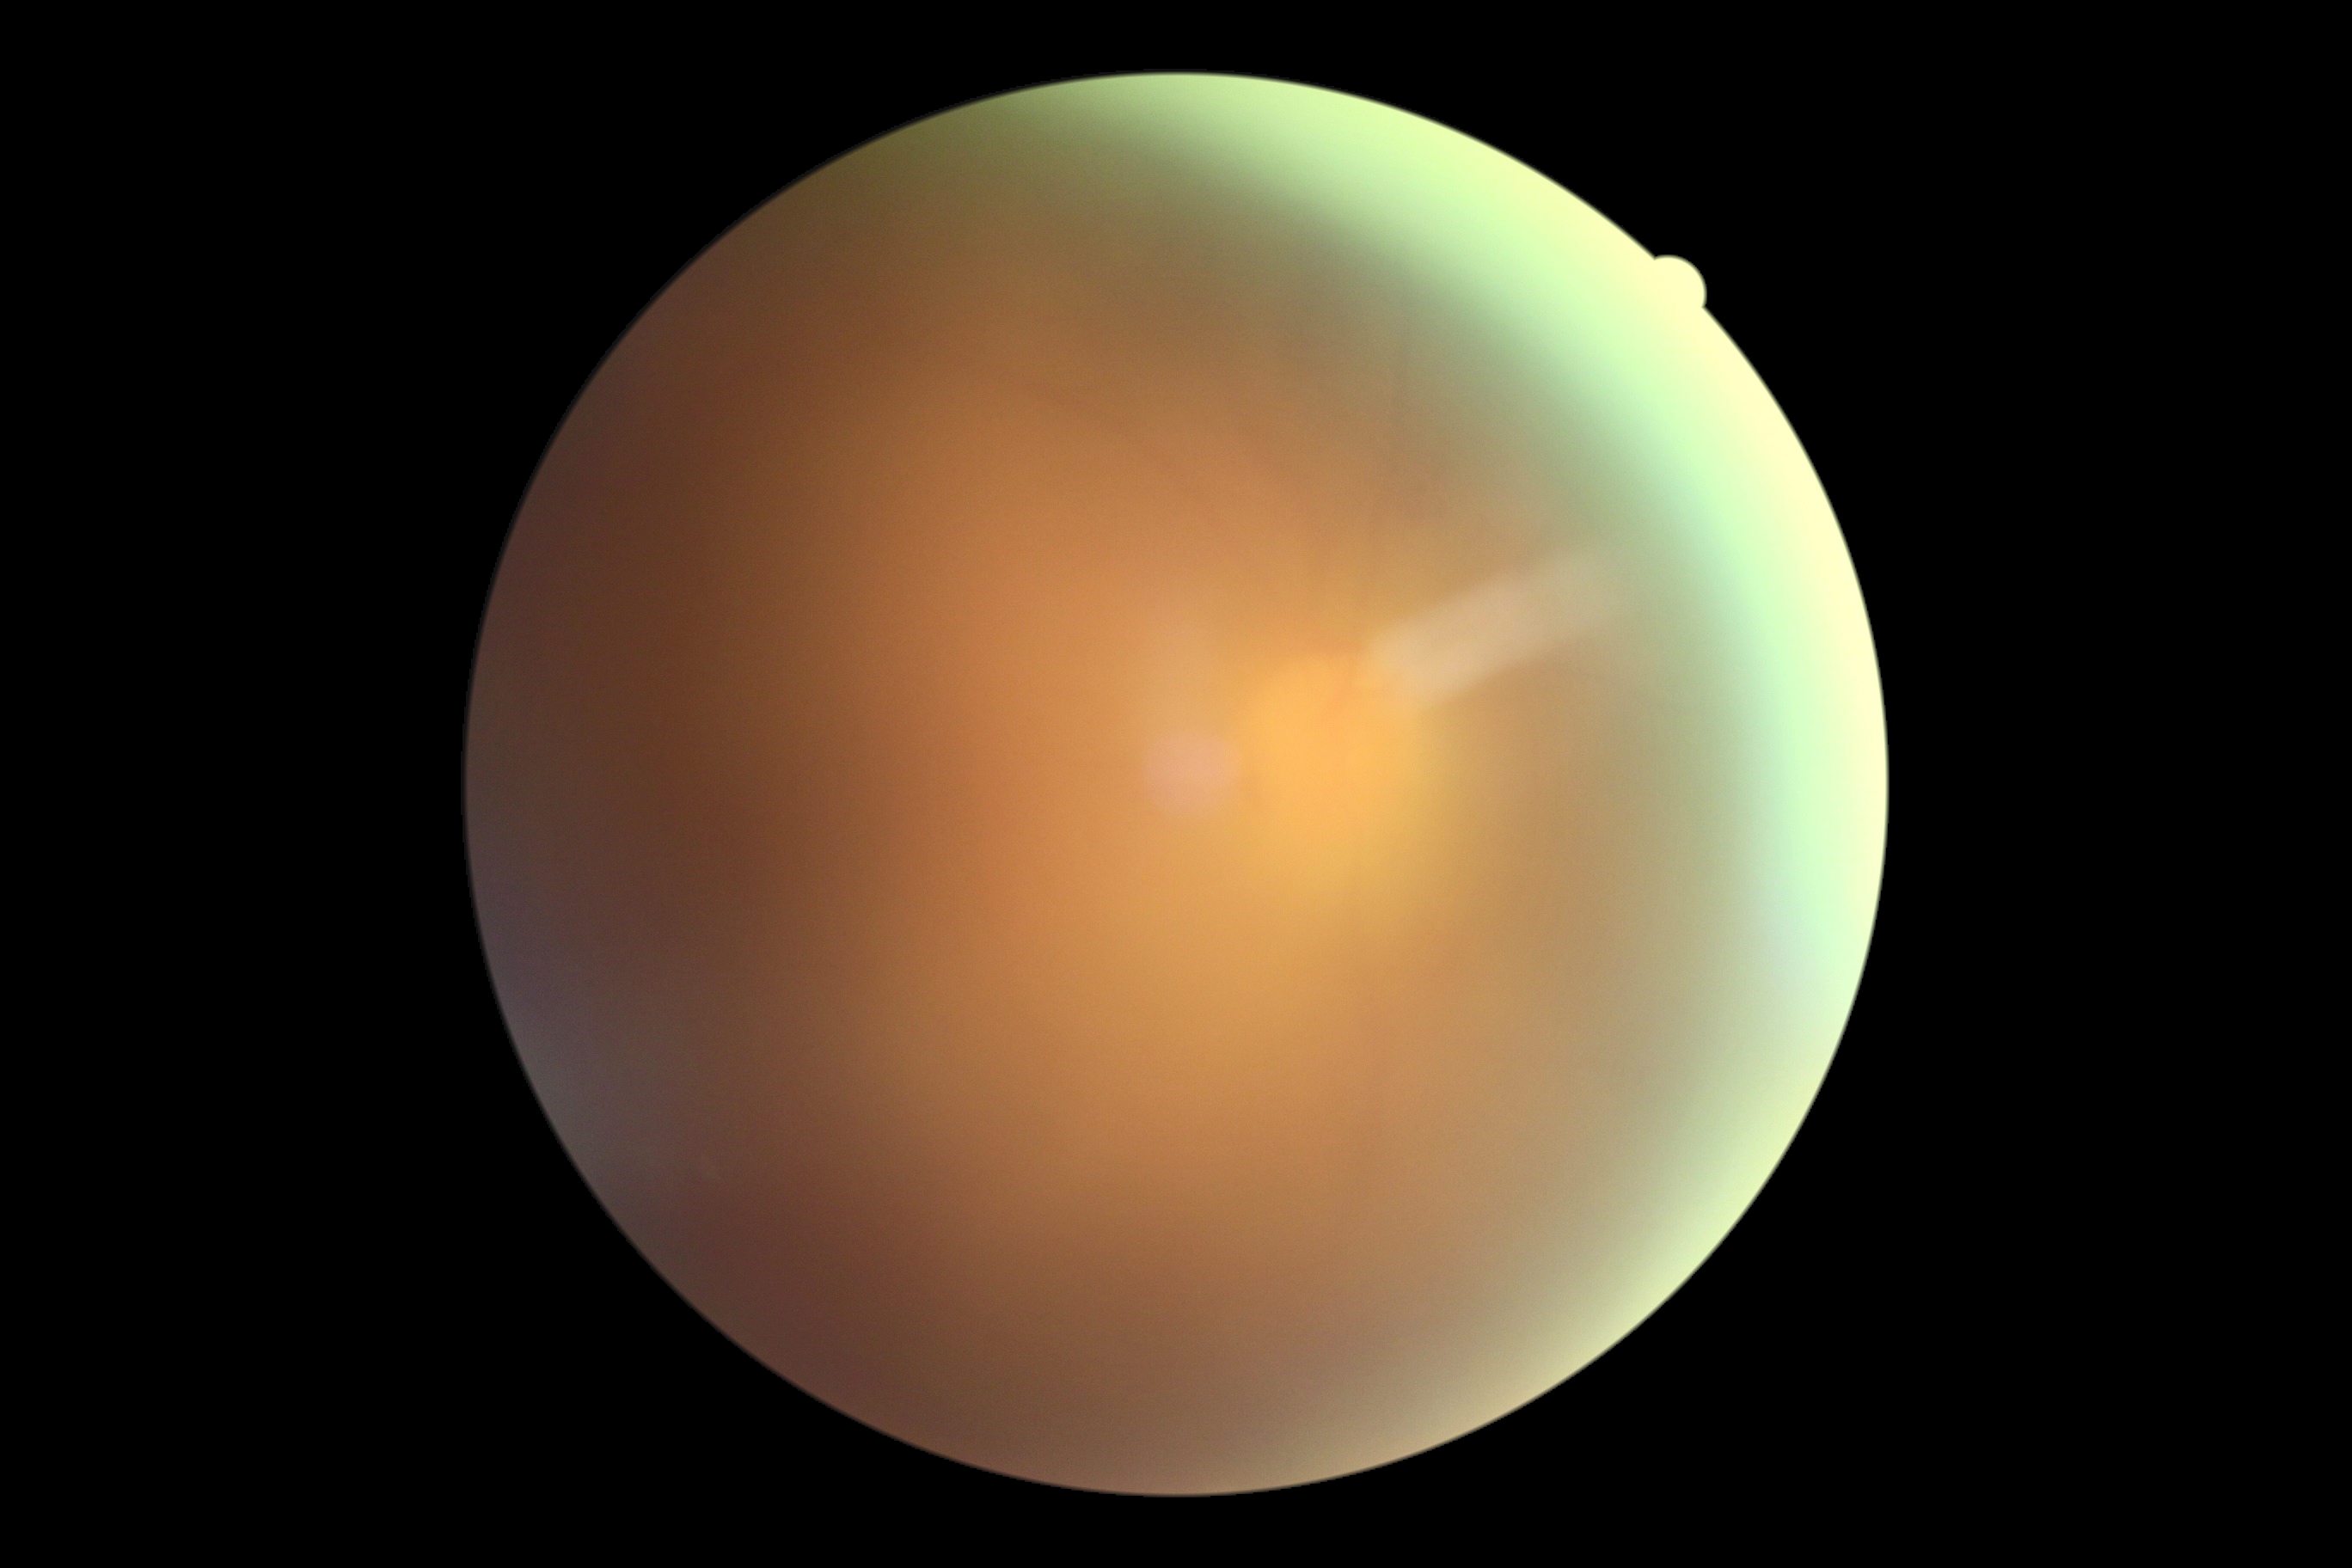
{"dr_grade": "ungradable due to poor image quality", "quality": "below grading threshold"}